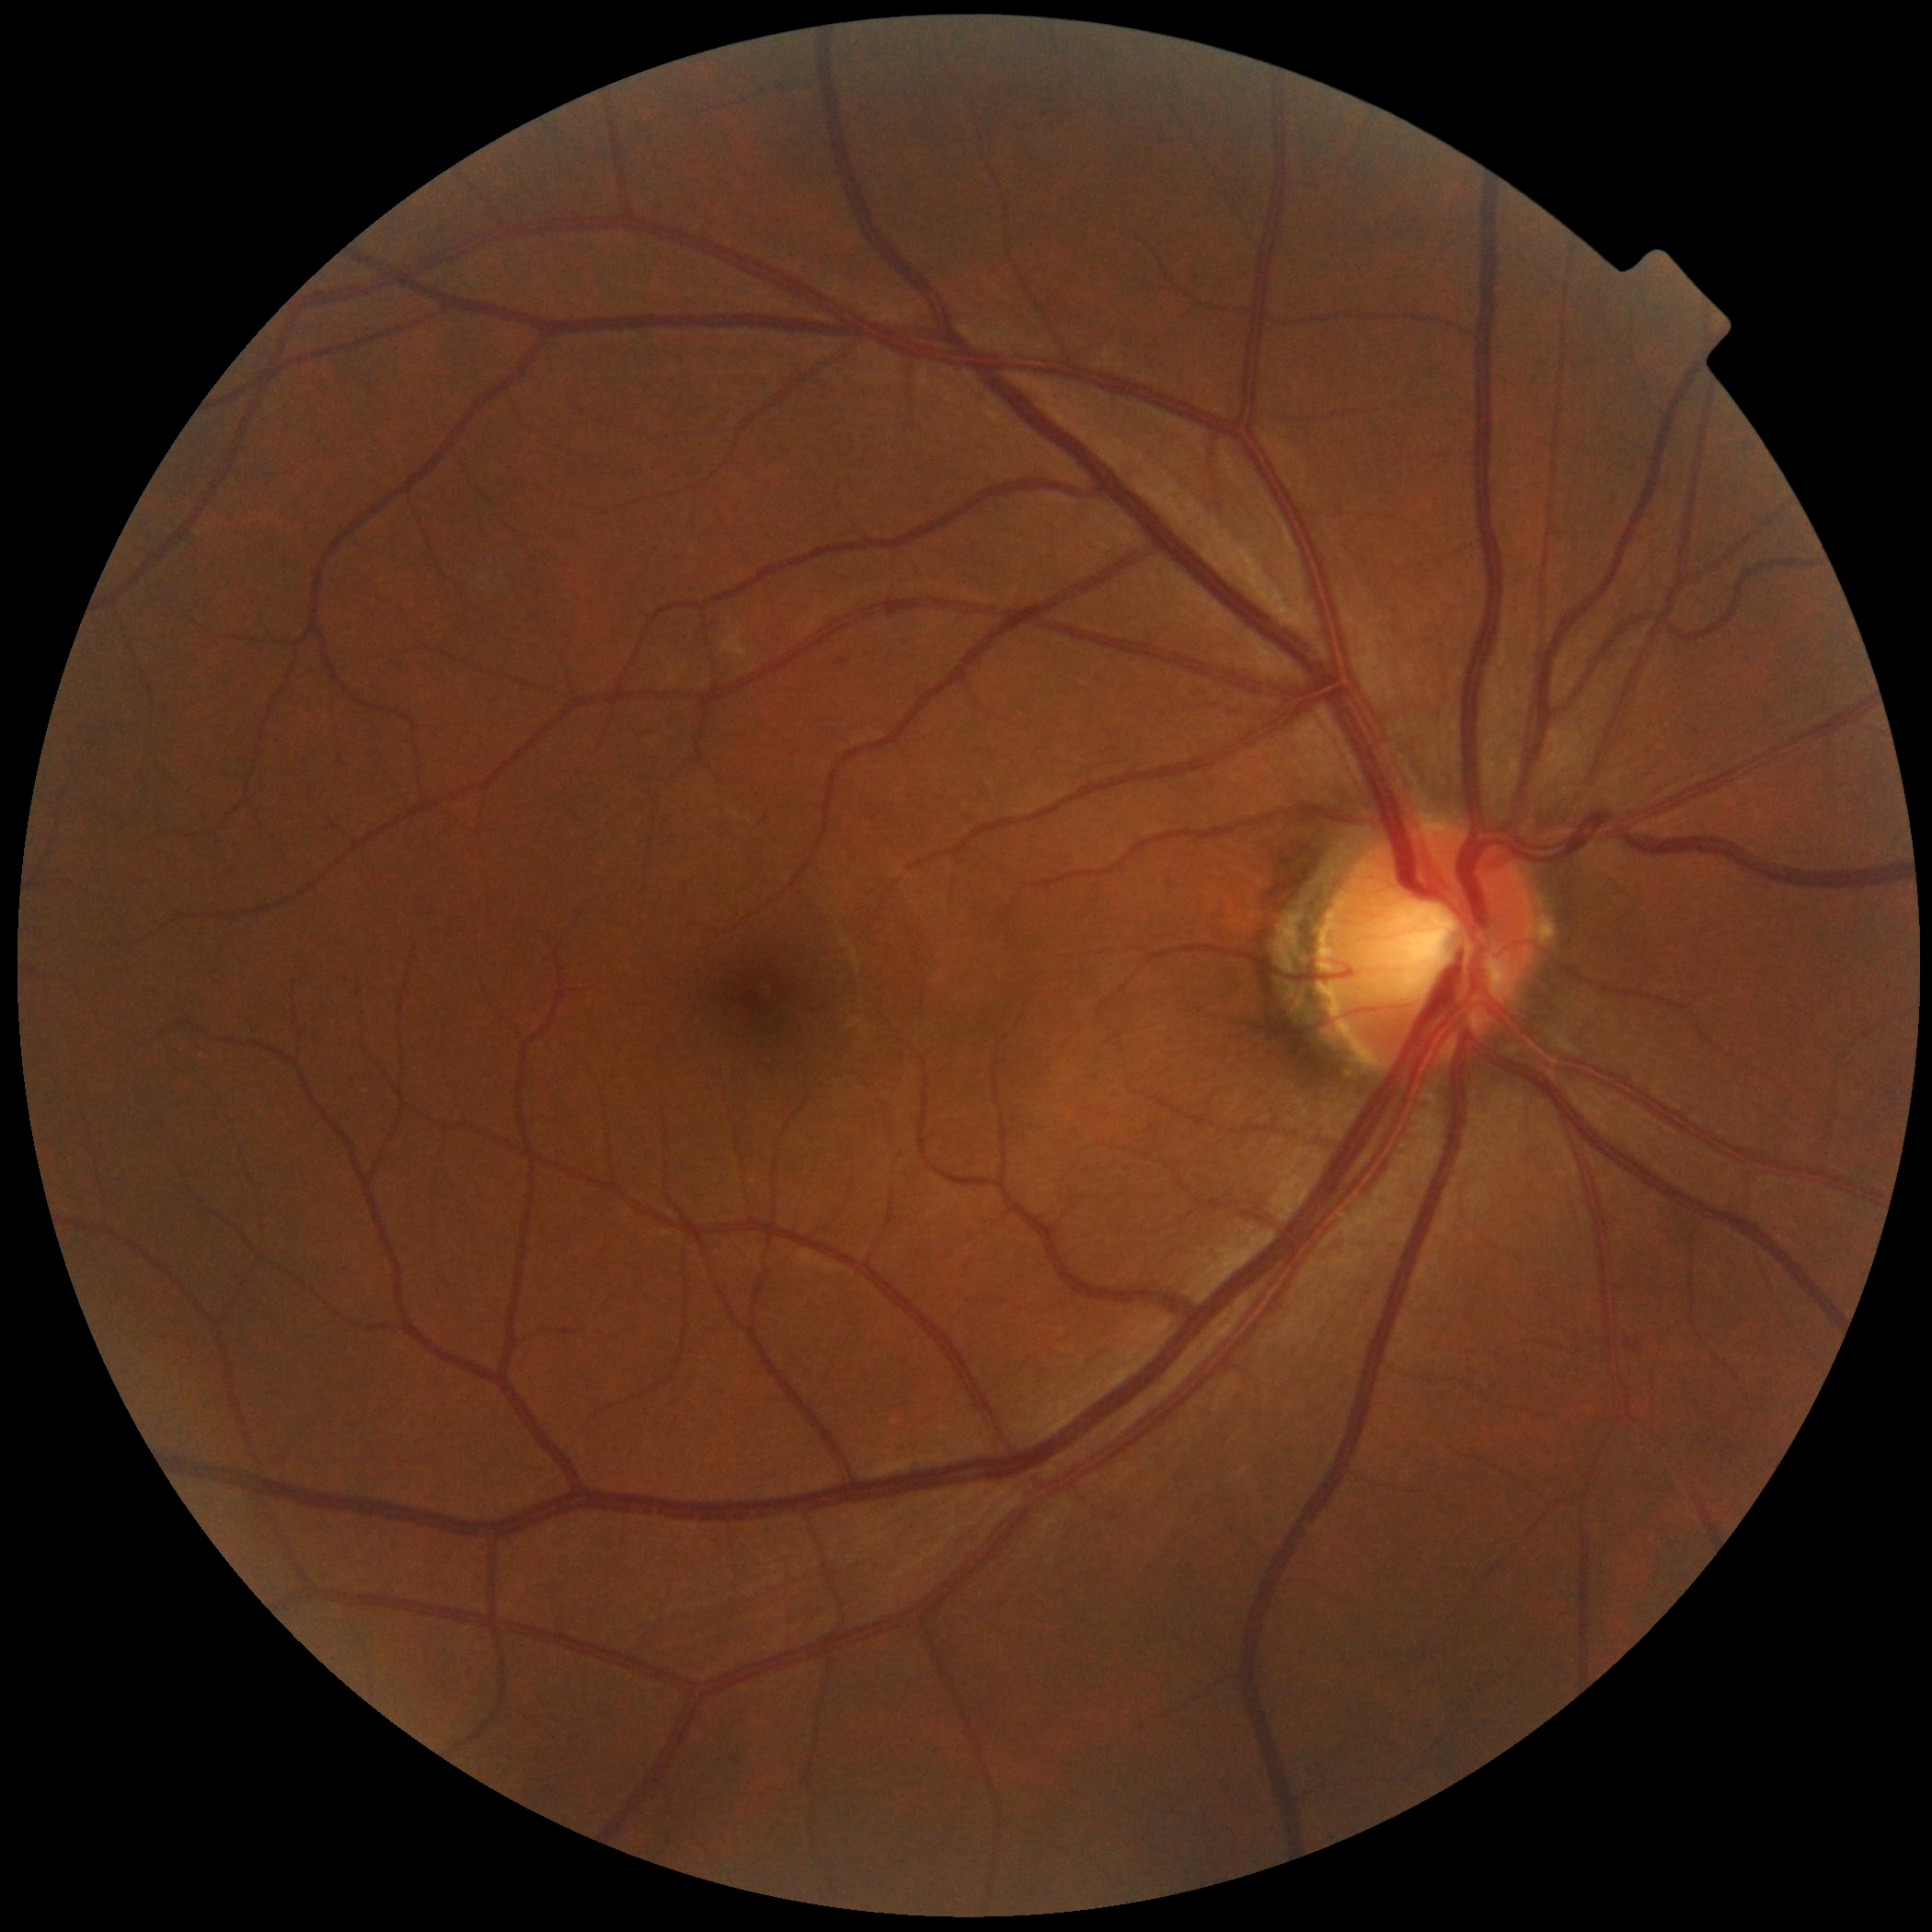

{"dr_grade": "2/4", "dr_category": "non-proliferative diabetic retinopathy"}